1504 x 1000 pixels: 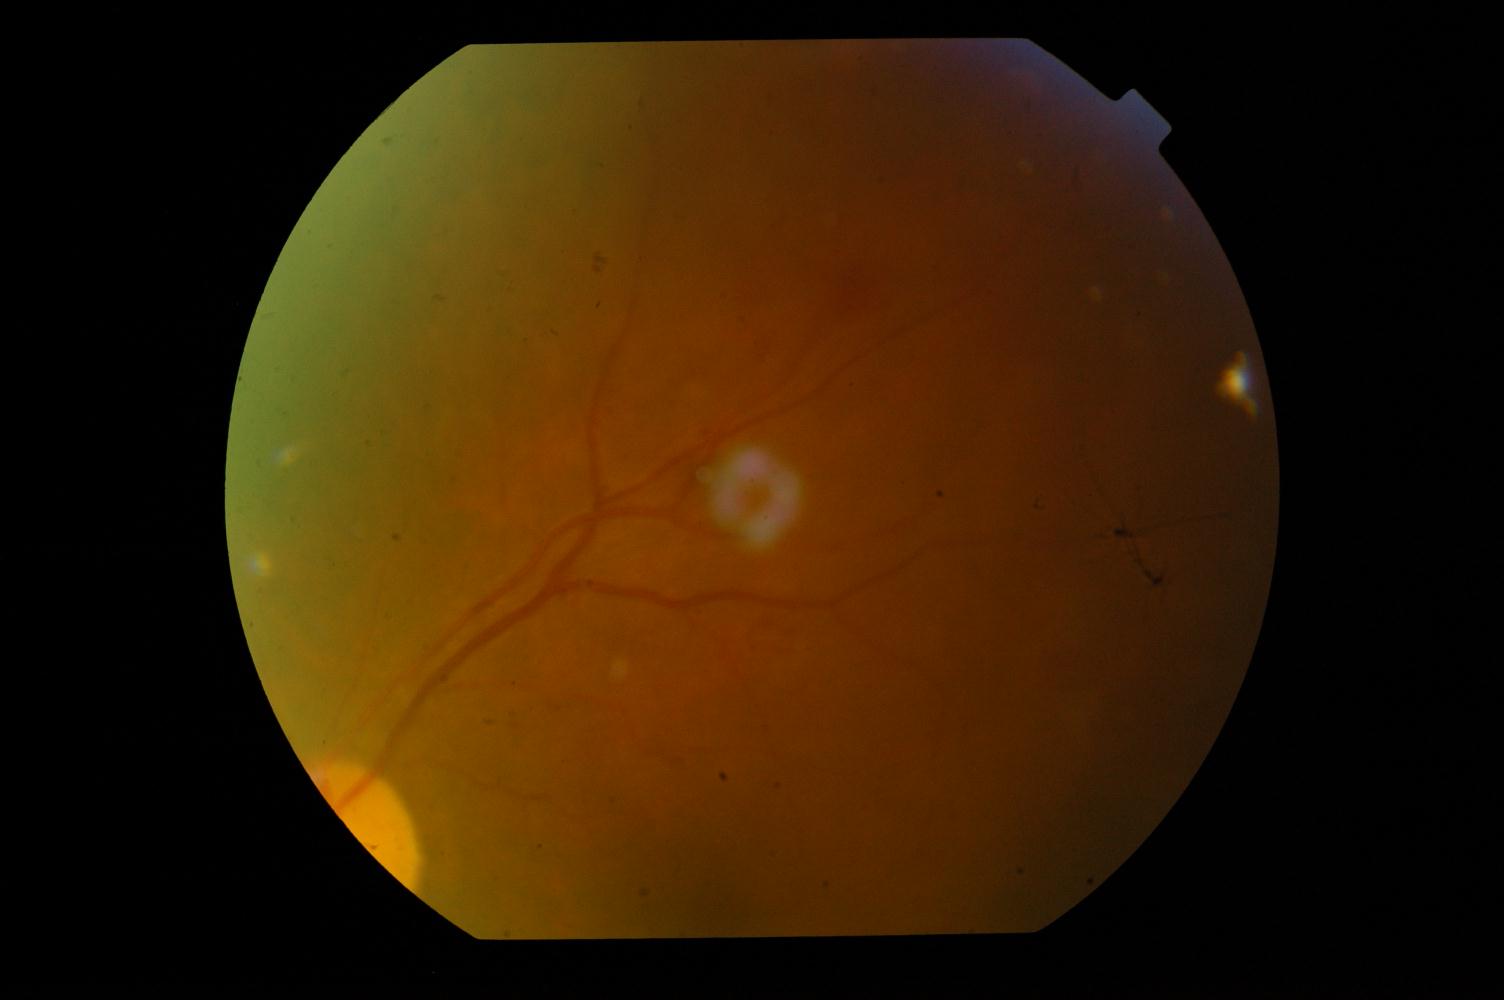
Diagnosis: diabetic retinopathy.